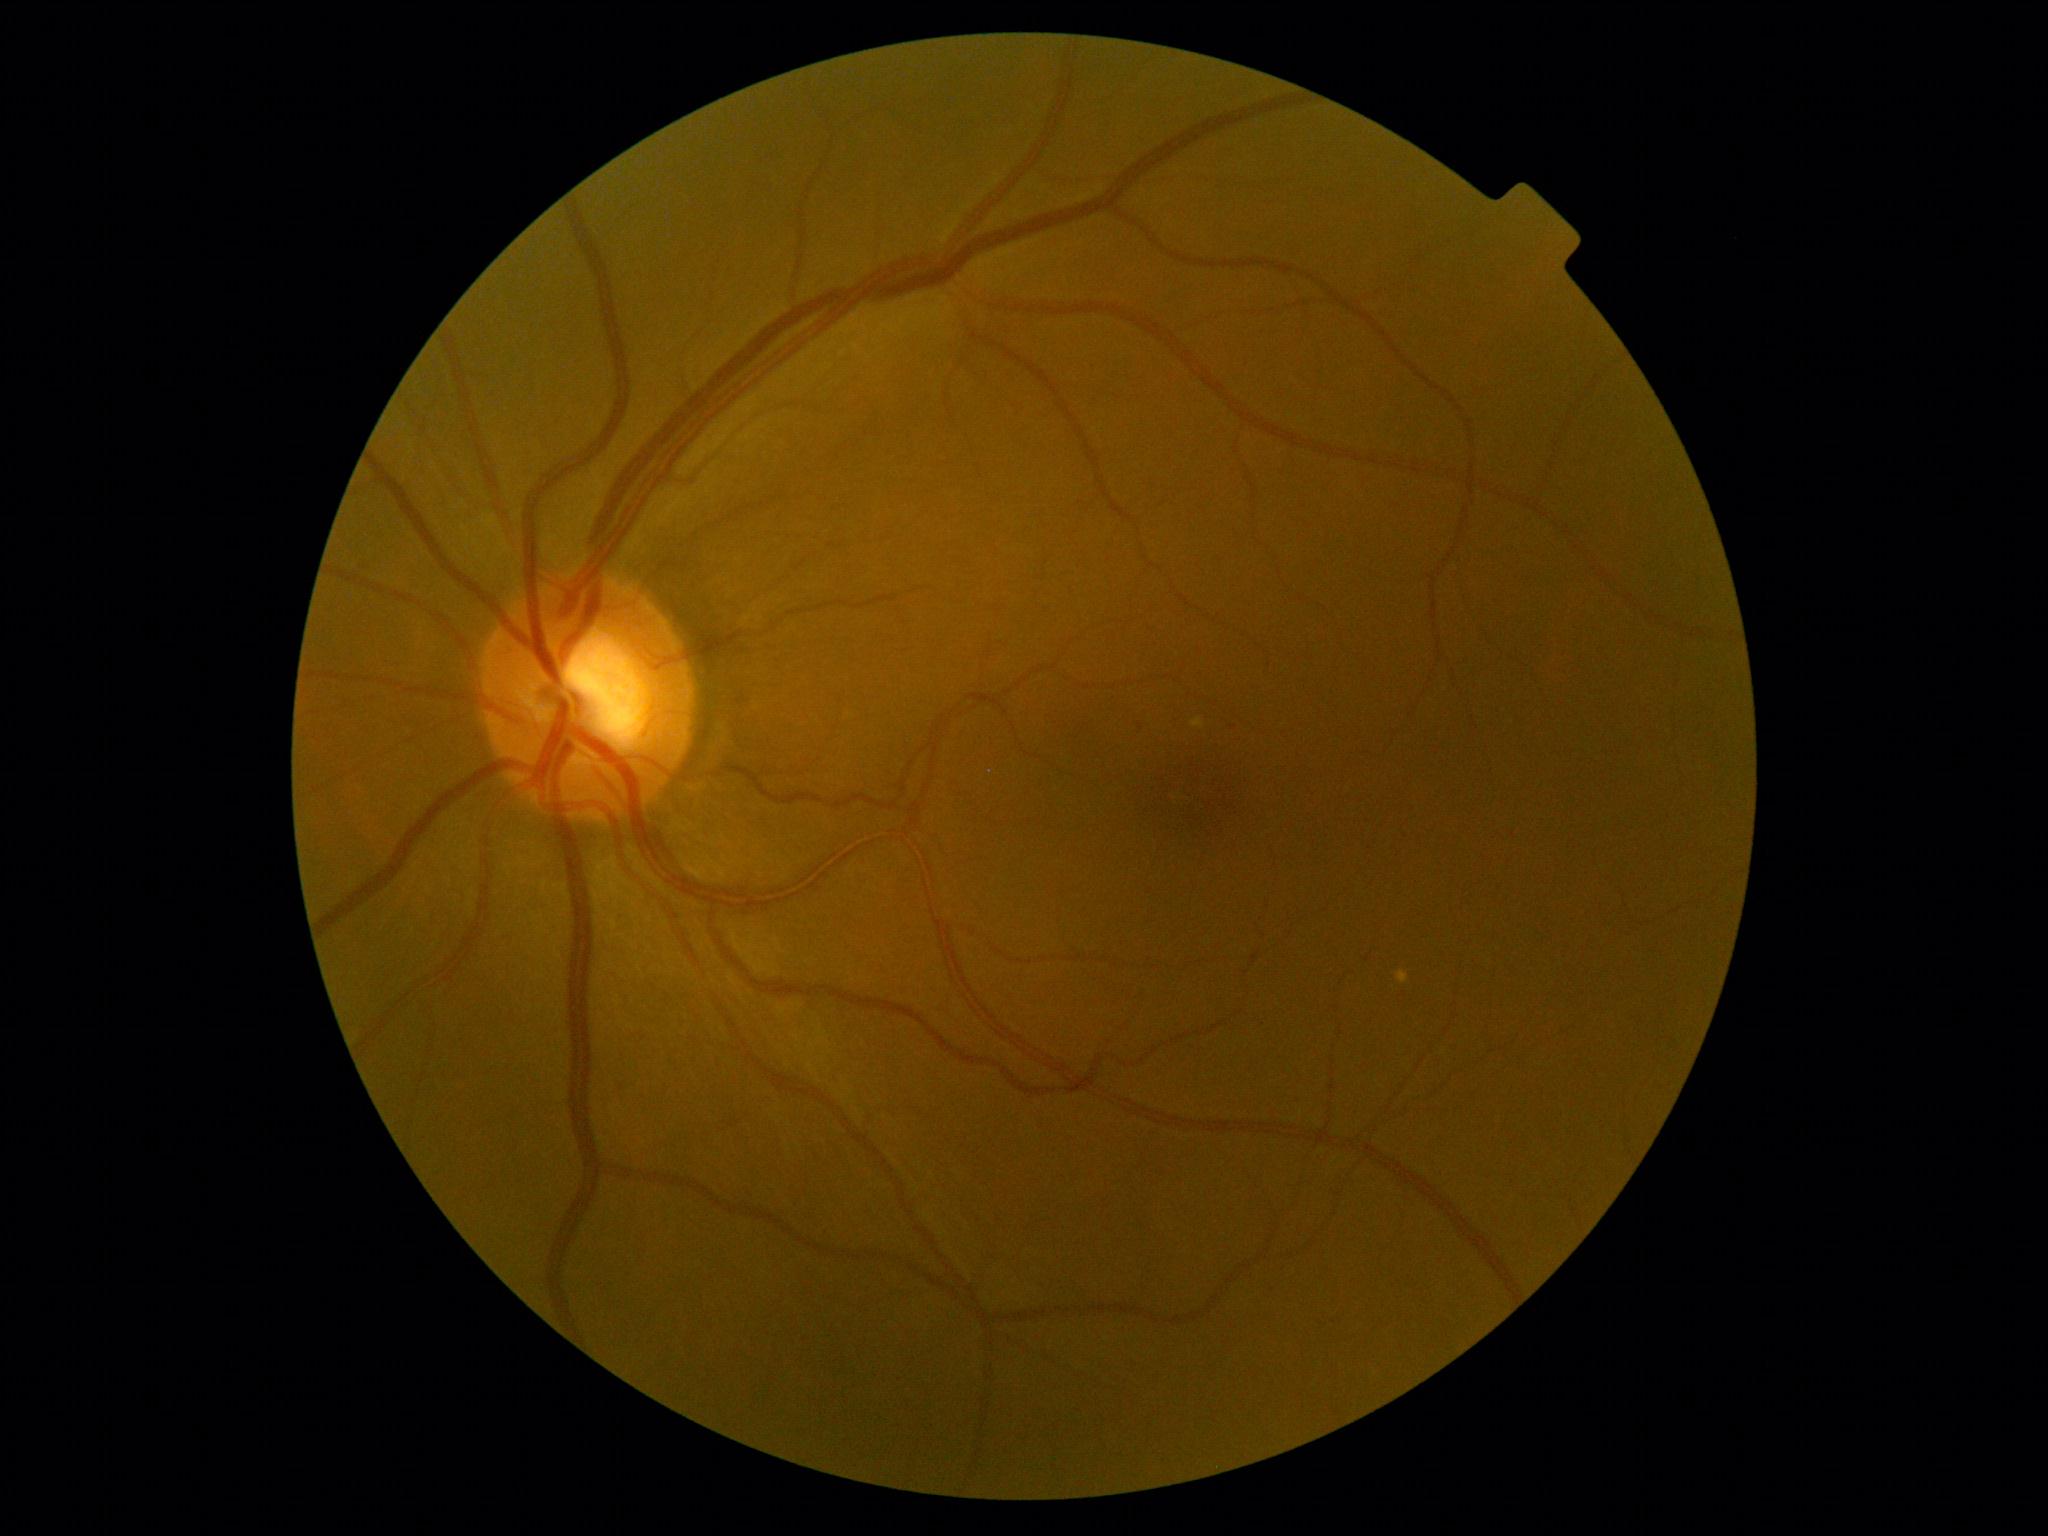 Diabetic retinopathy: 1/4.